FOV: 50 degrees.
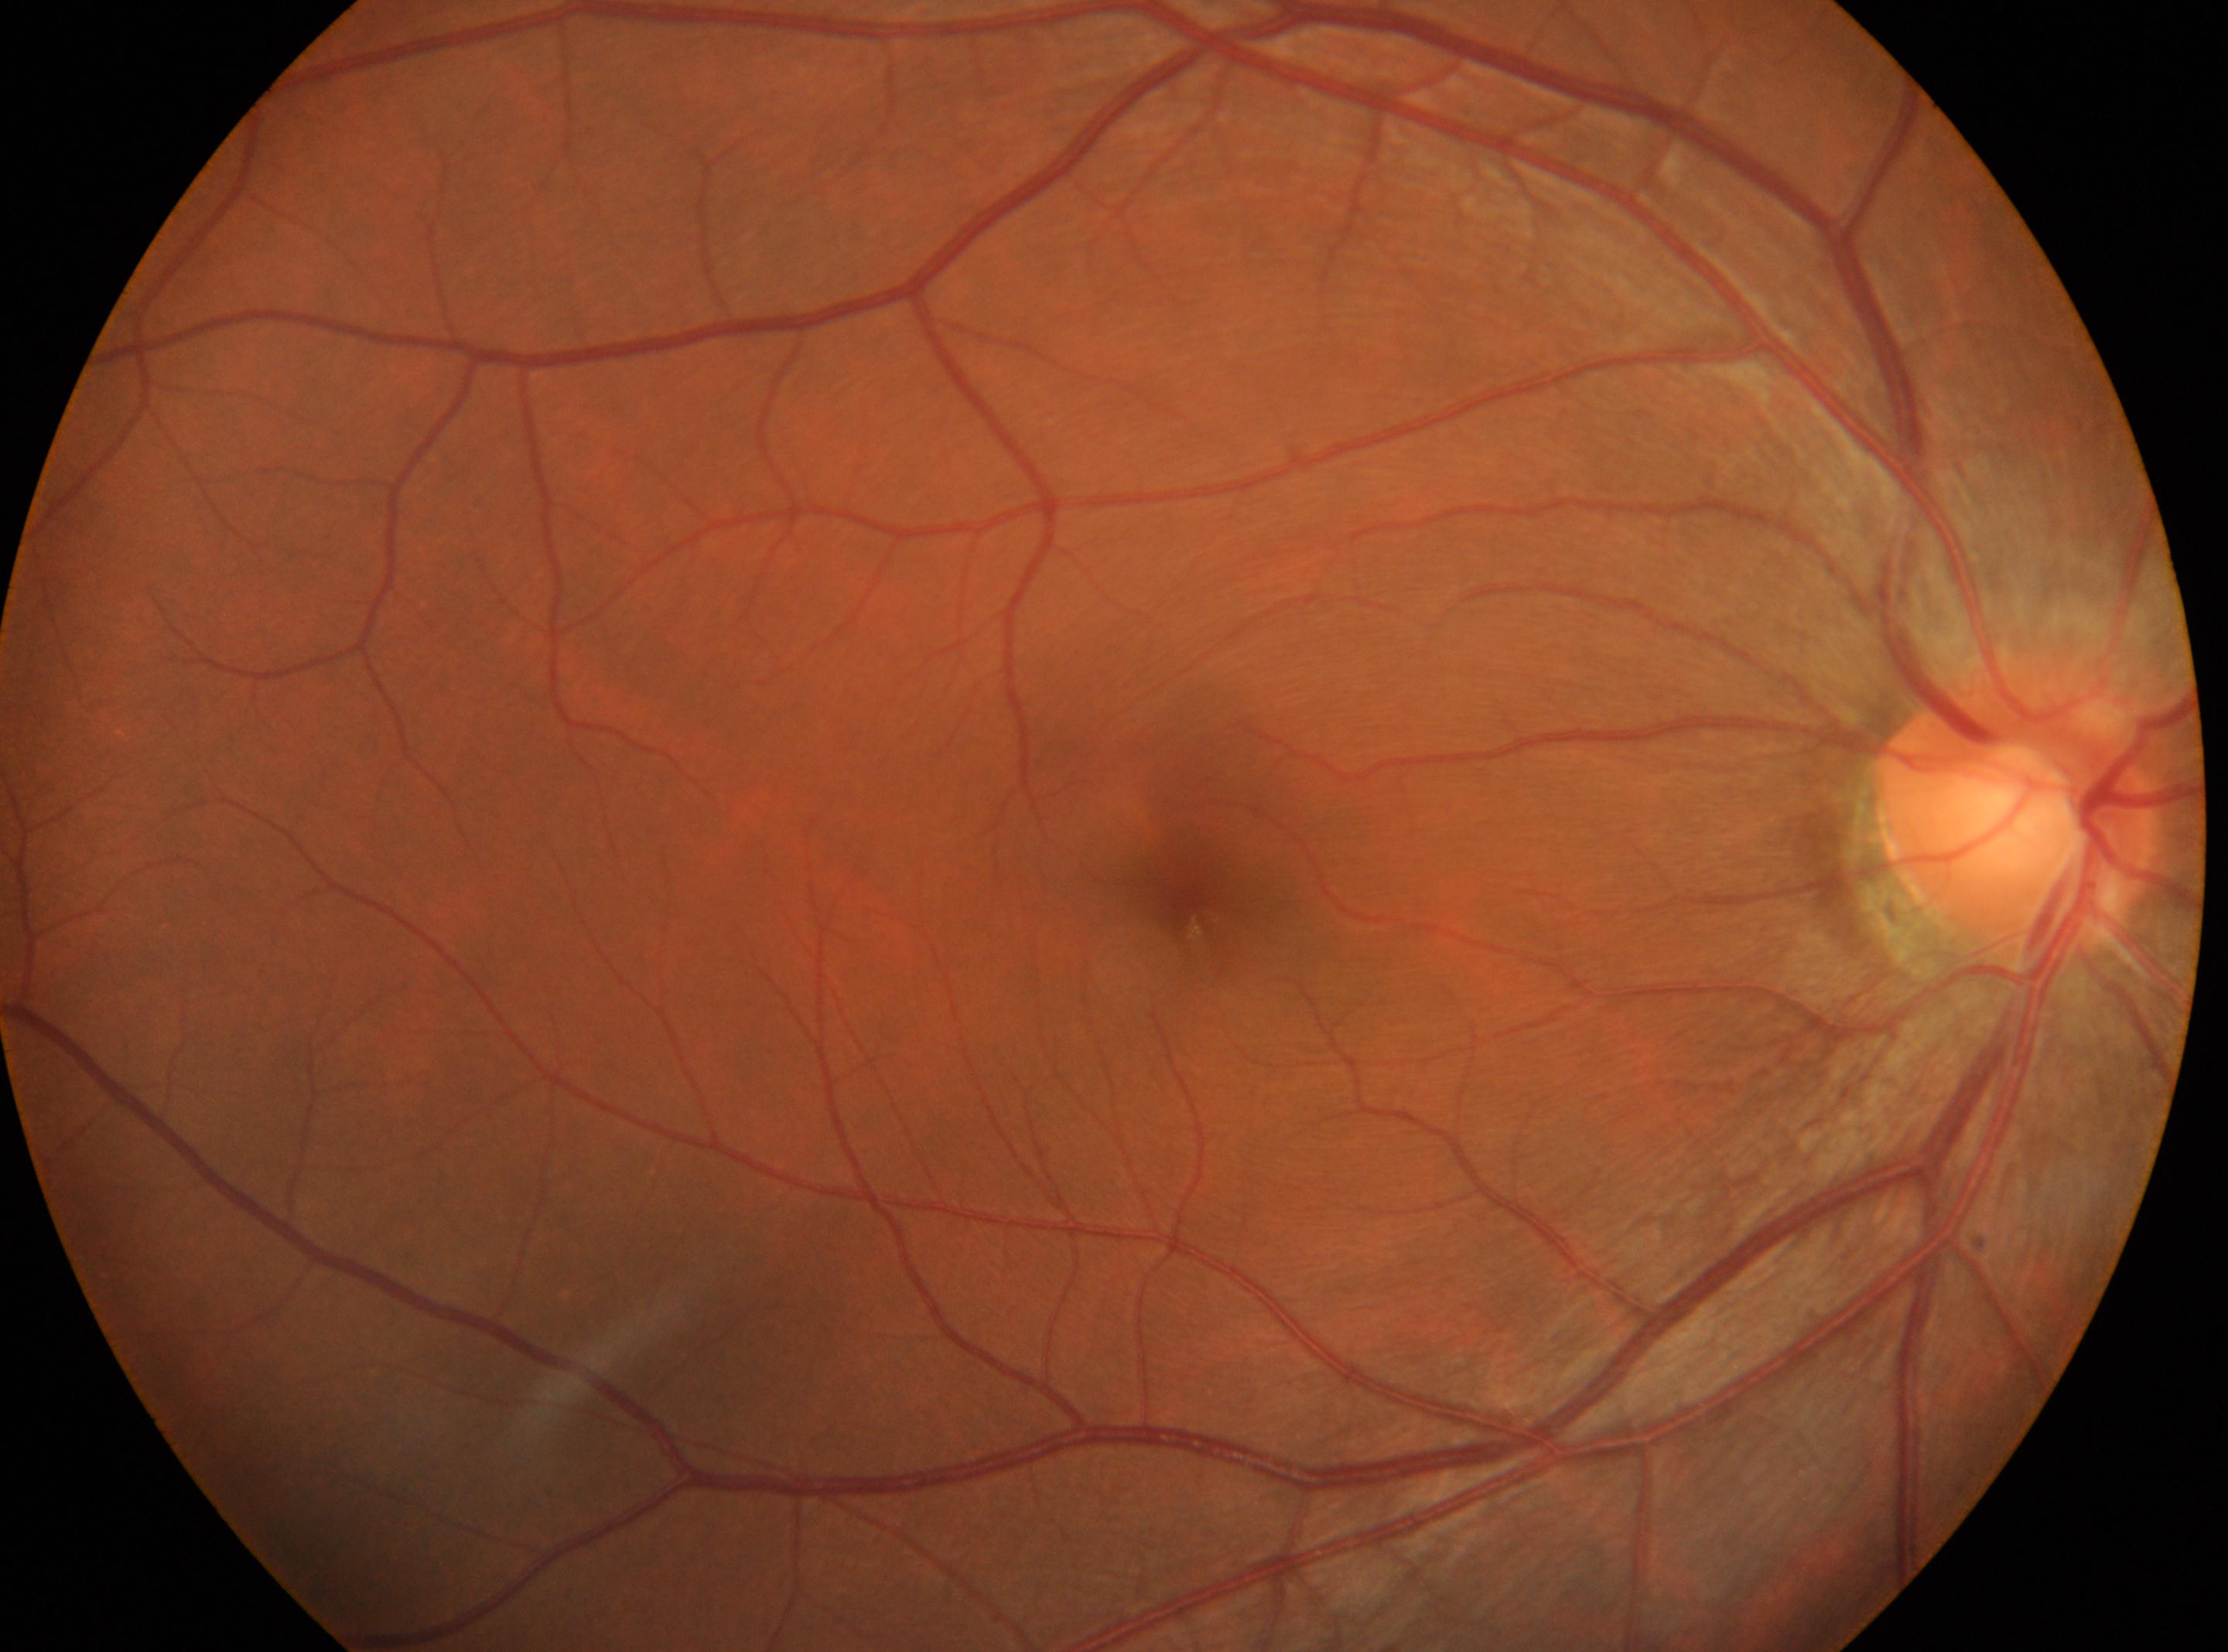
No diabetic retinopathy identified. Imaged eye: OD. The macula center is at [1190, 900]. Diabetic retinopathy (DR): grade 0 (no apparent retinopathy). Optic disc center located at [2014, 819].